Pediatric wide-field fundus photograph.
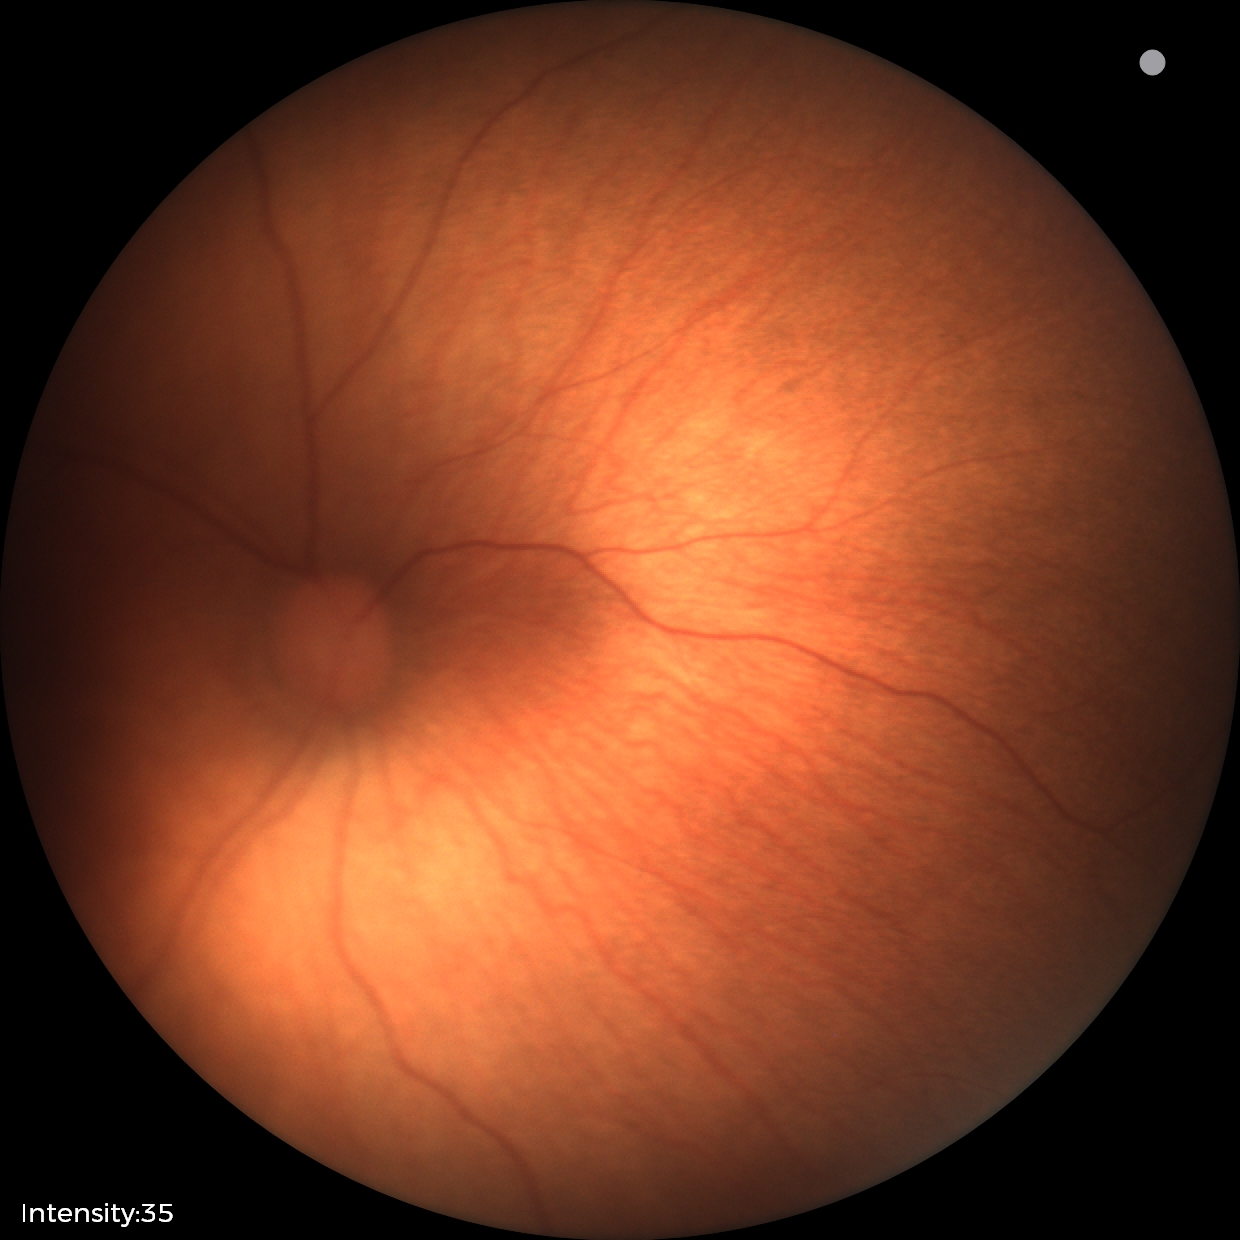
Impression: no pathology identified.